2102x1736:
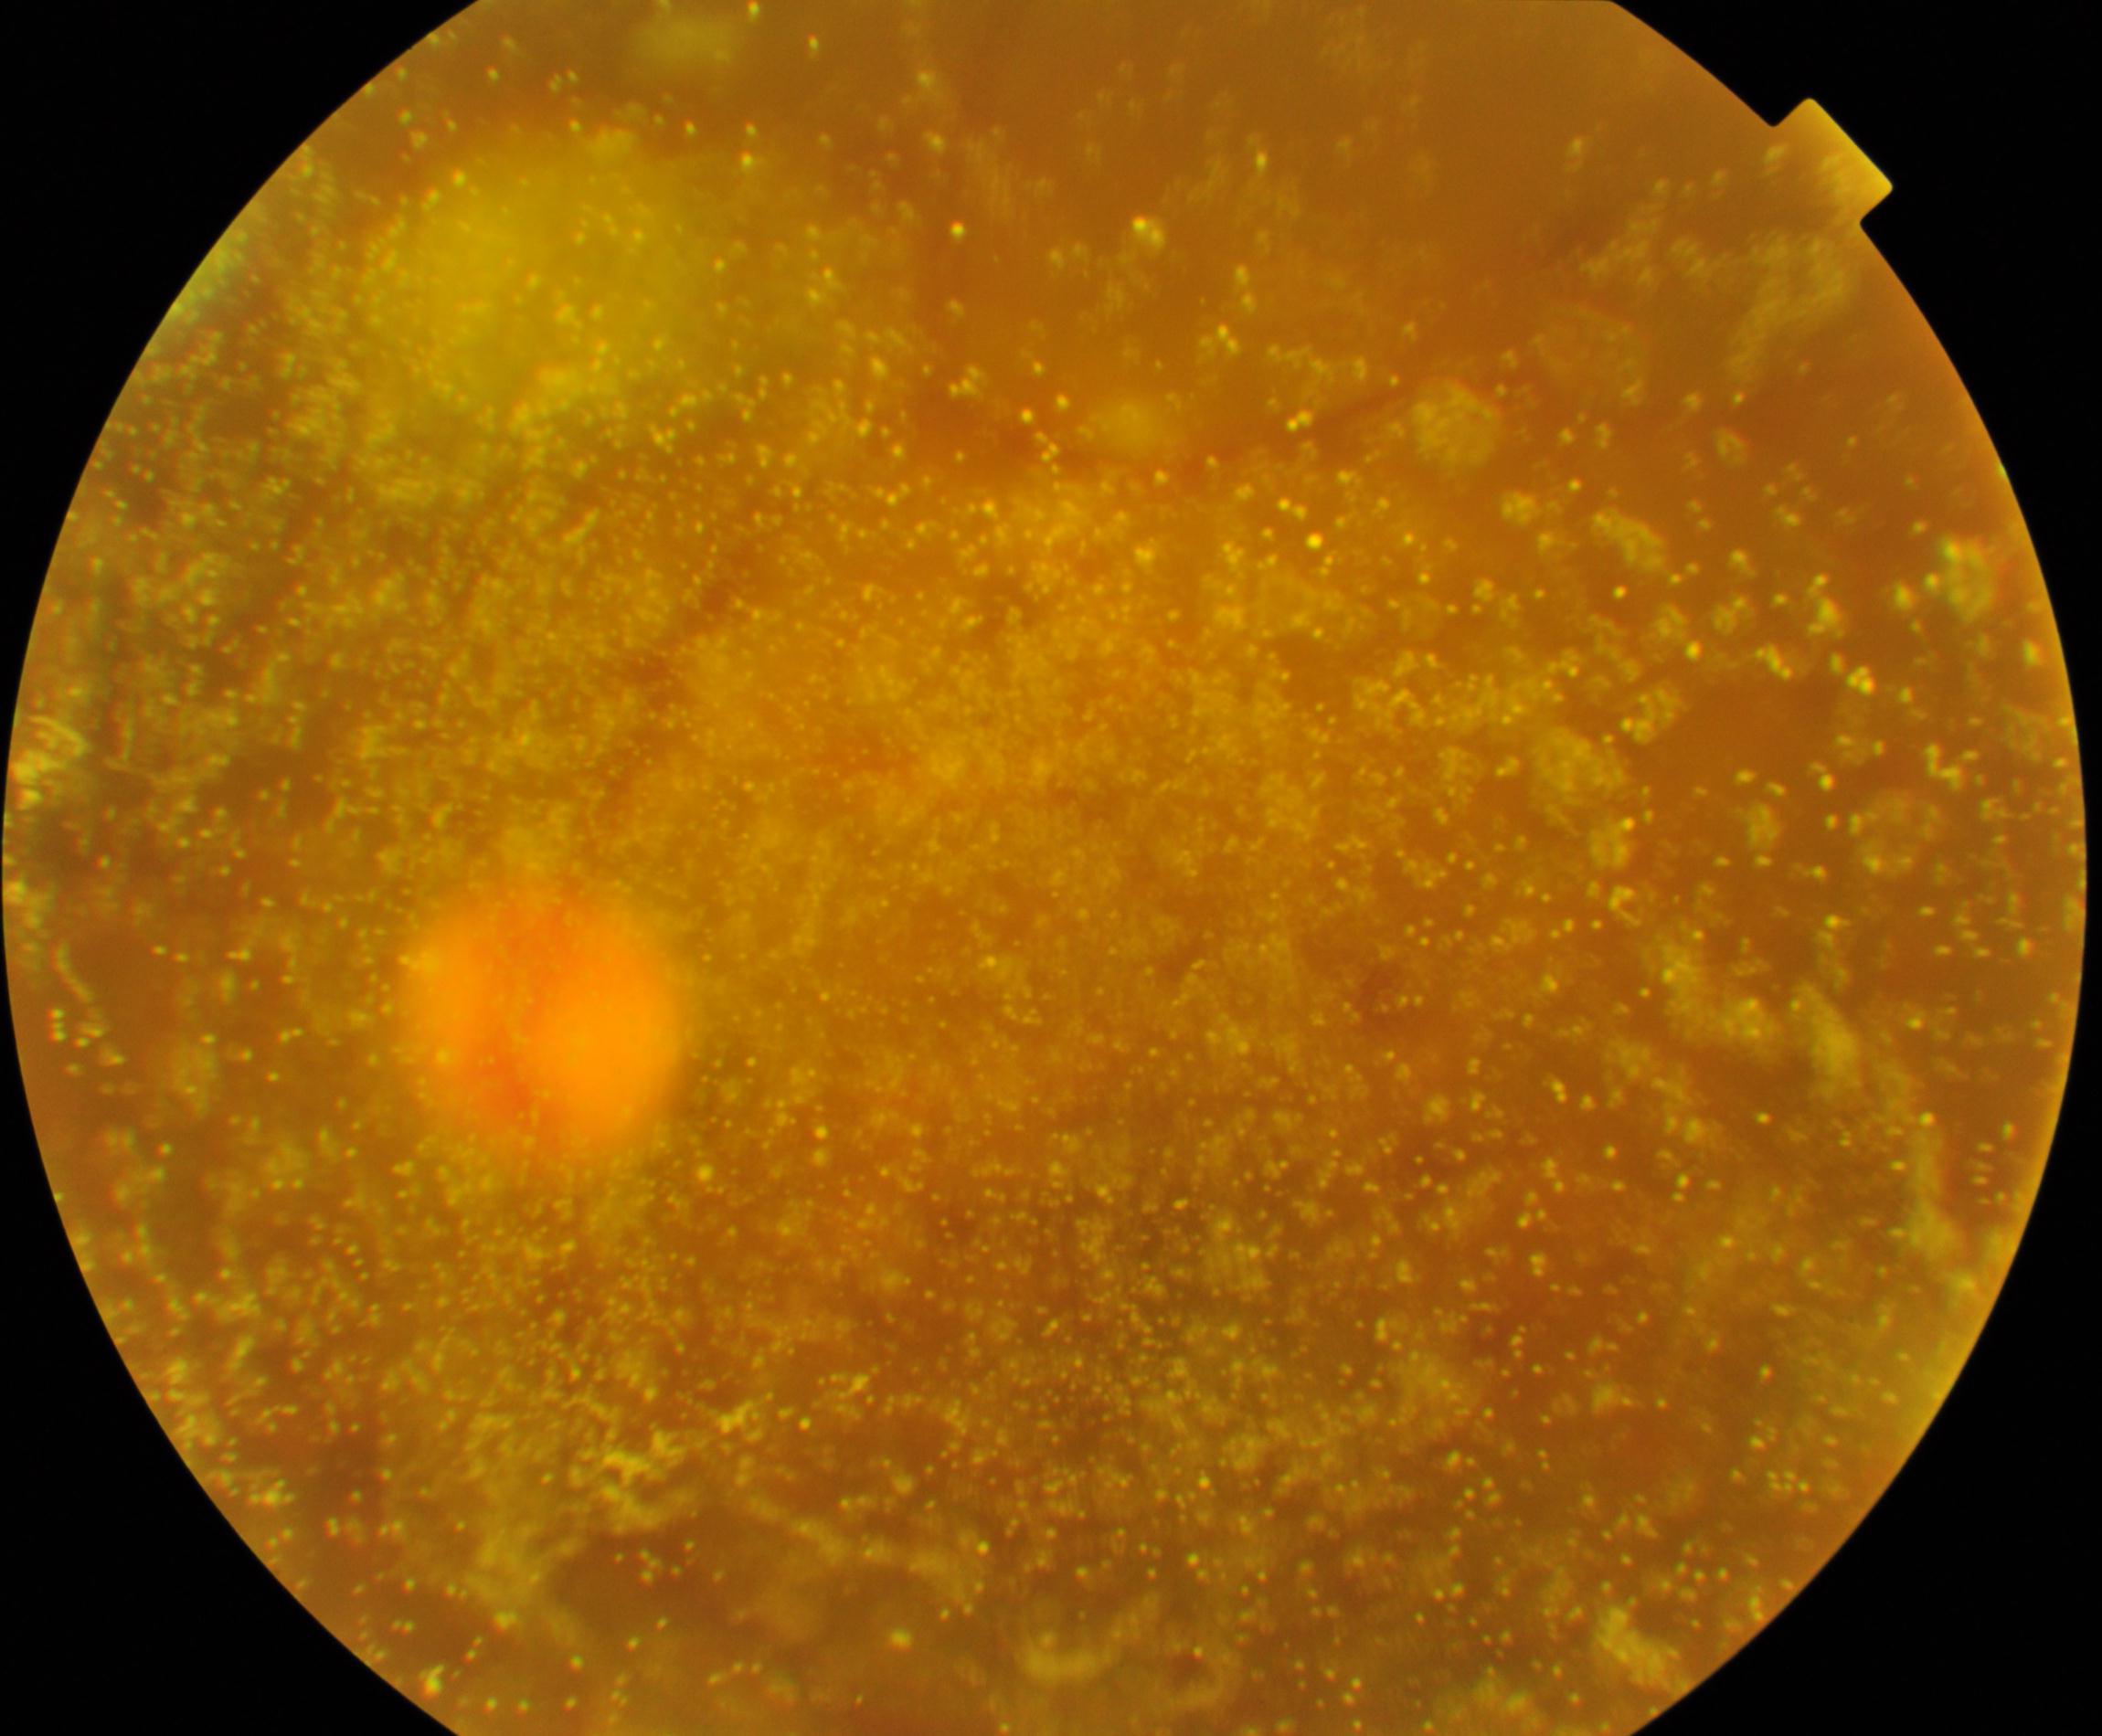

Appearance consistent with vitreous particles. Defined by vitreous opacities including asteroid hyalosis, synchysis scintillans, and deposits of familial amyloidosis.